Without pupil dilation. CFP:
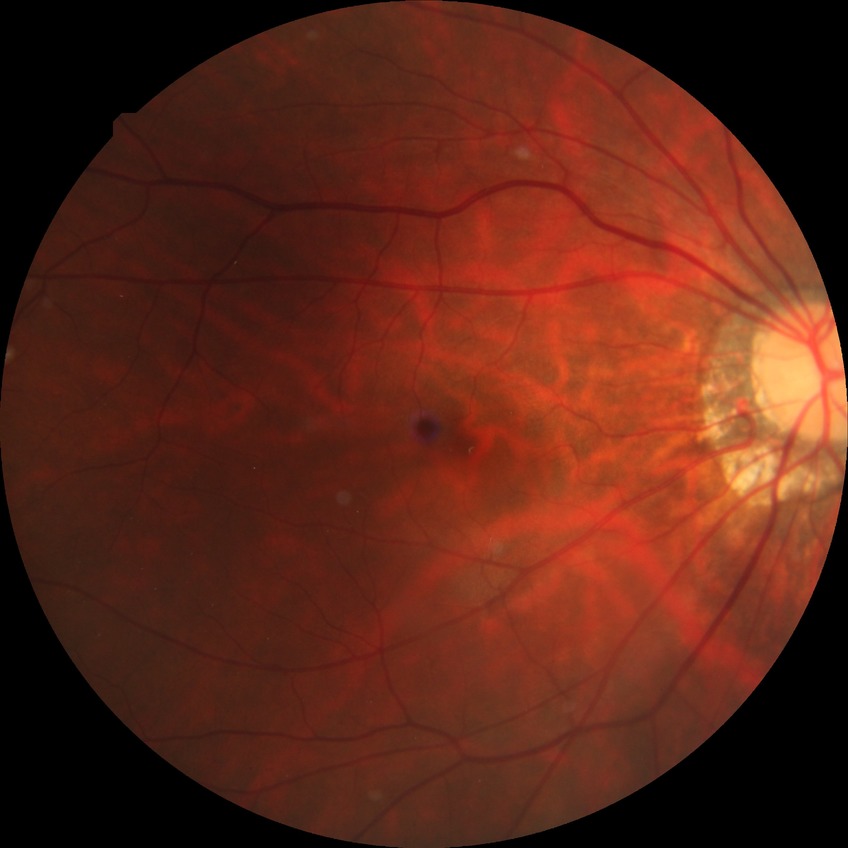 diabetic retinopathy severity: no diabetic retinopathy